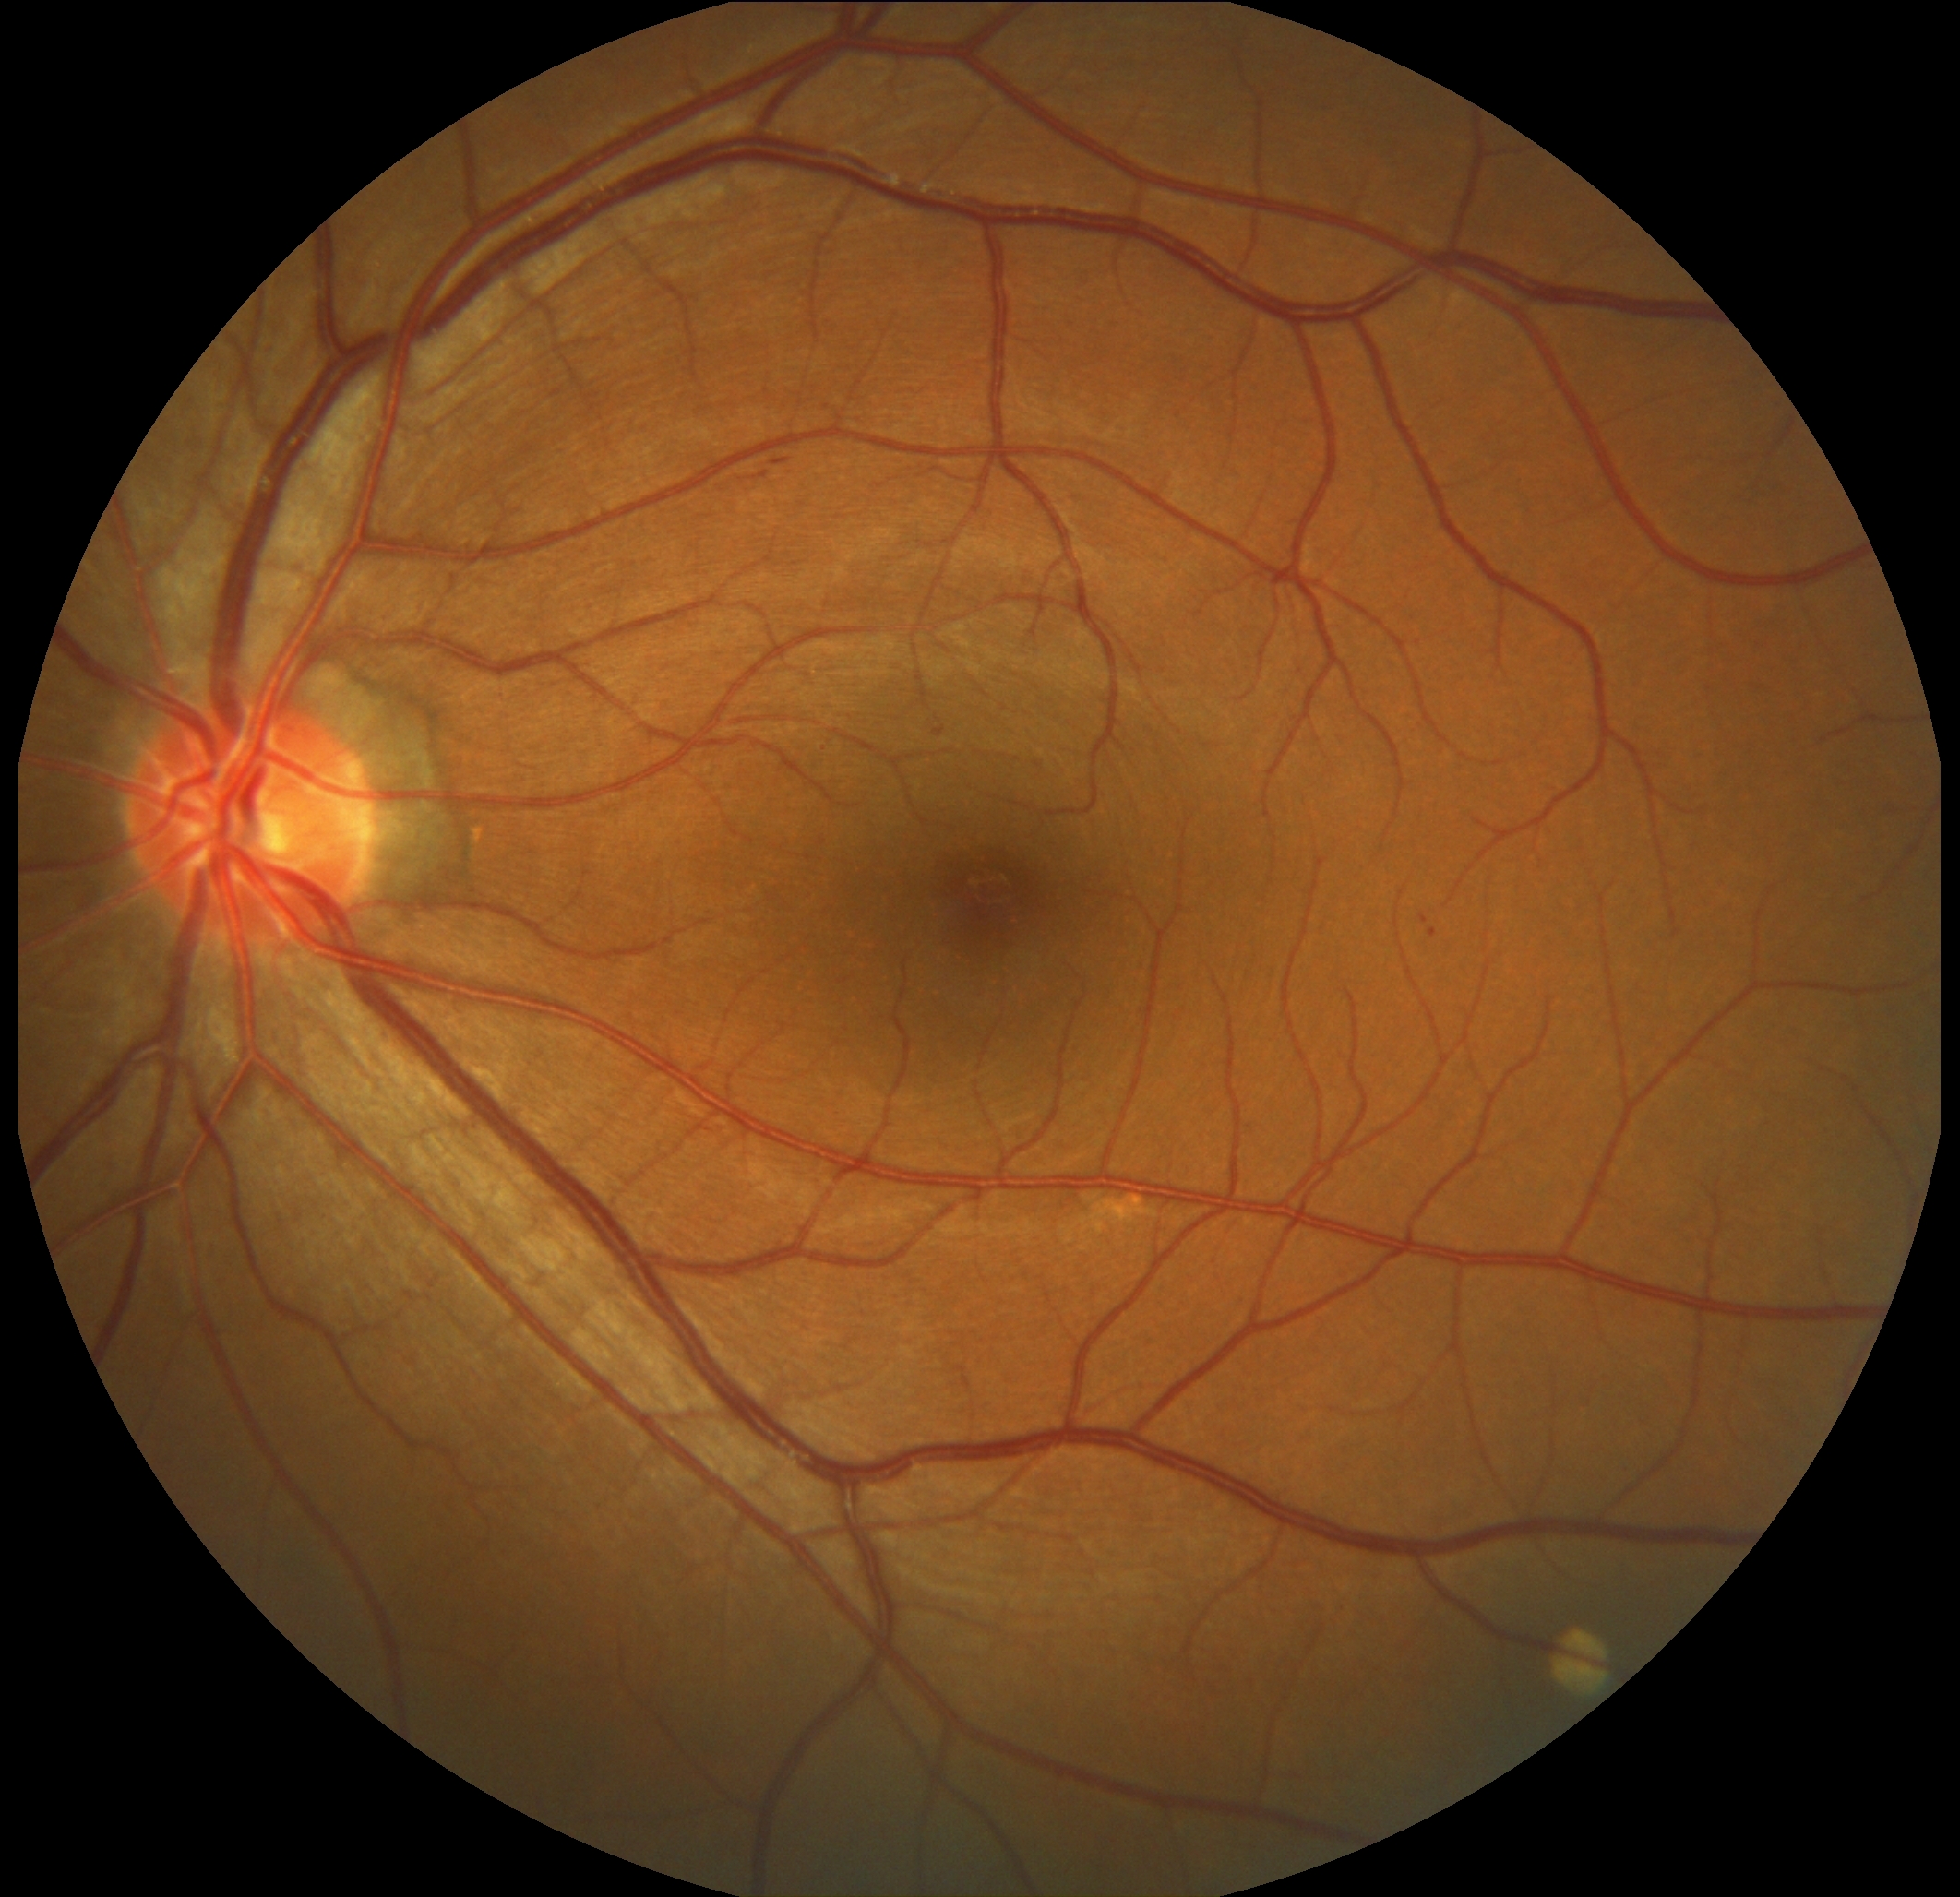 diabetic retinopathy severity: 2